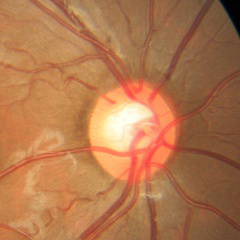 Impression = no glaucomatous optic neuropathy.